Pediatric retinal photograph (wide-field). Image size 1440x1080:
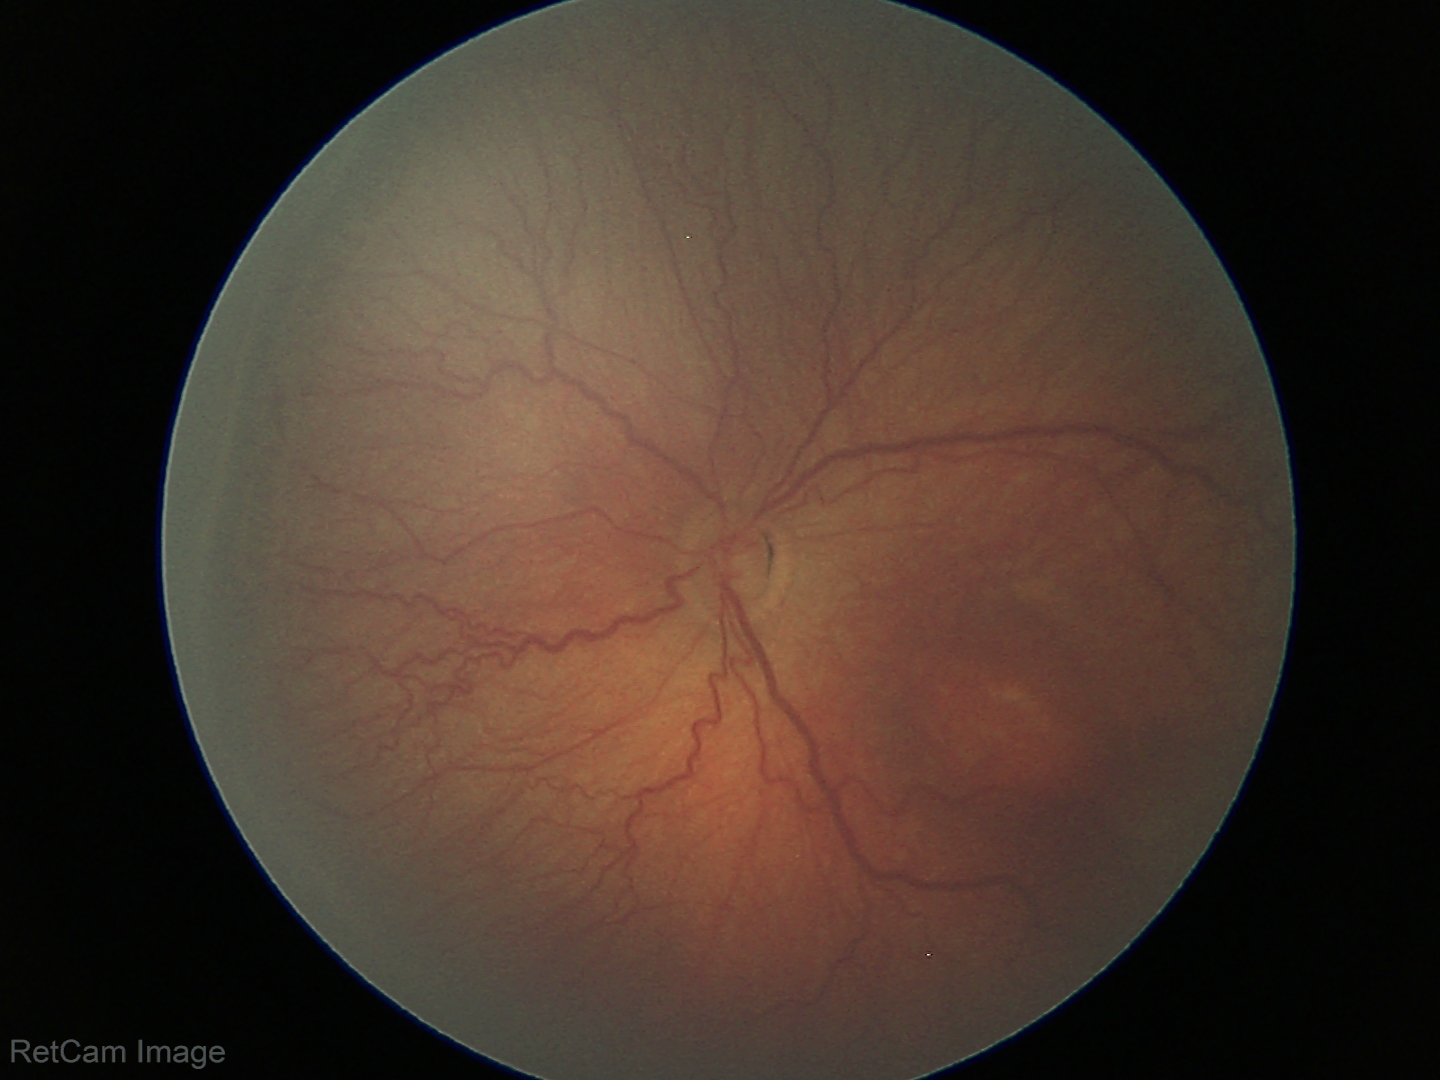

Plus form = absent — posterior pole vessels without abnormal dilation or tortuosity
ROP stage = 3 — ridge with extraretinal fibrovascular proliferation